Acquired on the Phoenix ICON. Pediatric wide-field fundus photograph. Image size 1240x1240
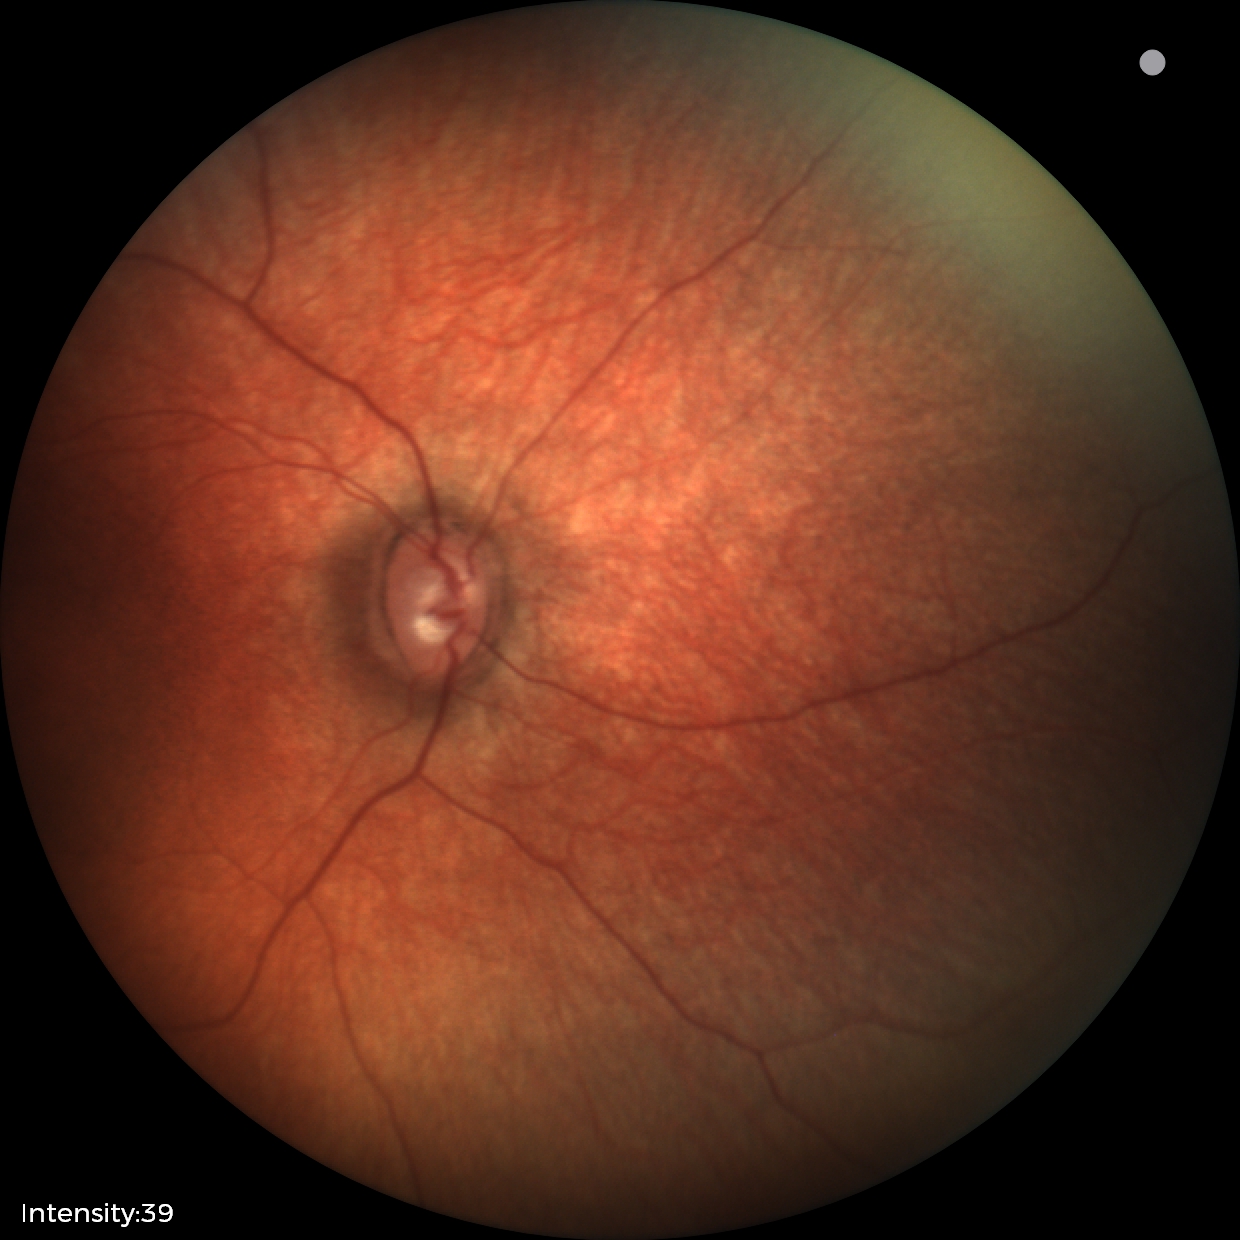
Q: What was the screening finding?
A: physiological appearance with no retinal pathology